45-degree field of view; NIDEK AFC-230; posterior pole photograph; nonmydriatic fundus photograph; image size 848x848:
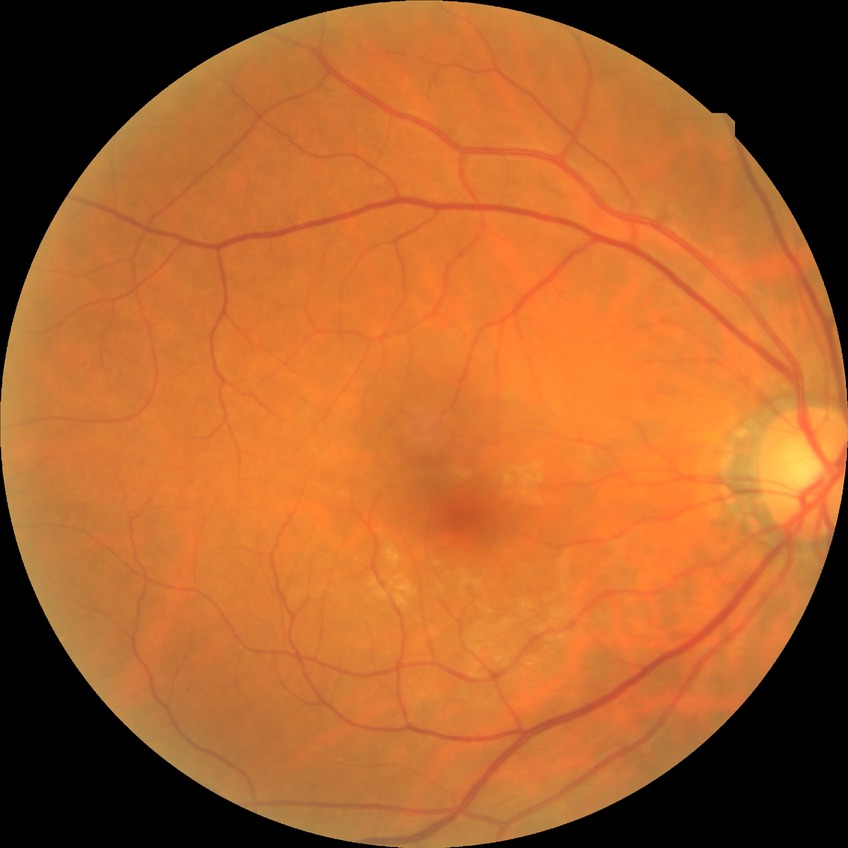 DR grade: NDR.